DR severity per modified Davis staging. Fundus photo. NIDEK AFC-230. 848 by 848 pixels. Nonmydriatic fundus photograph.
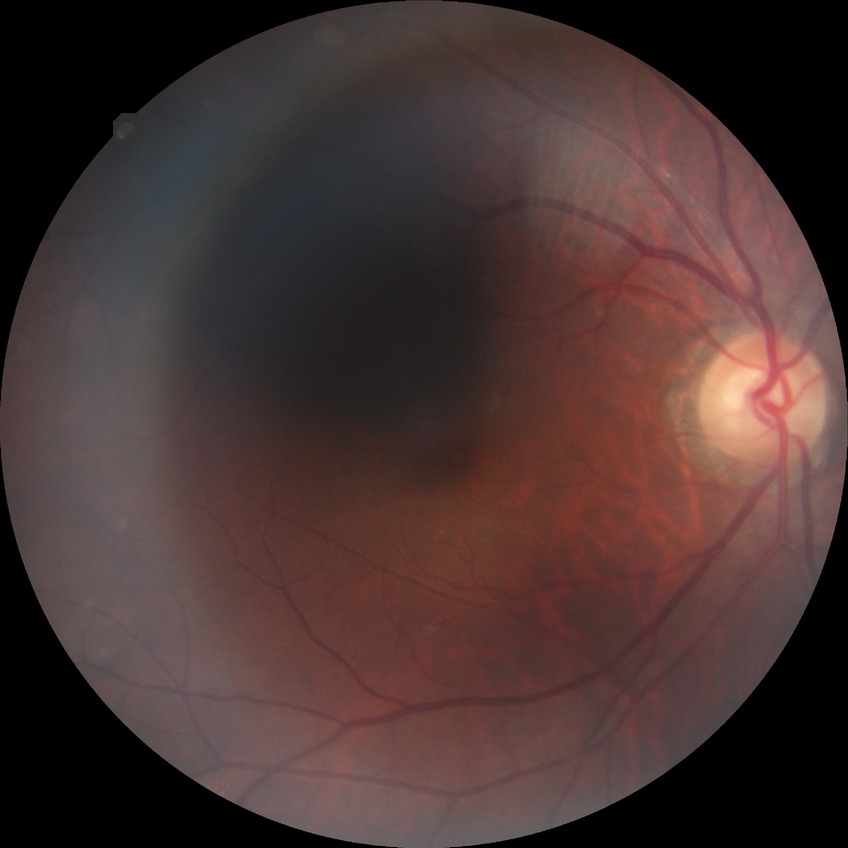

DR severity is SDR.